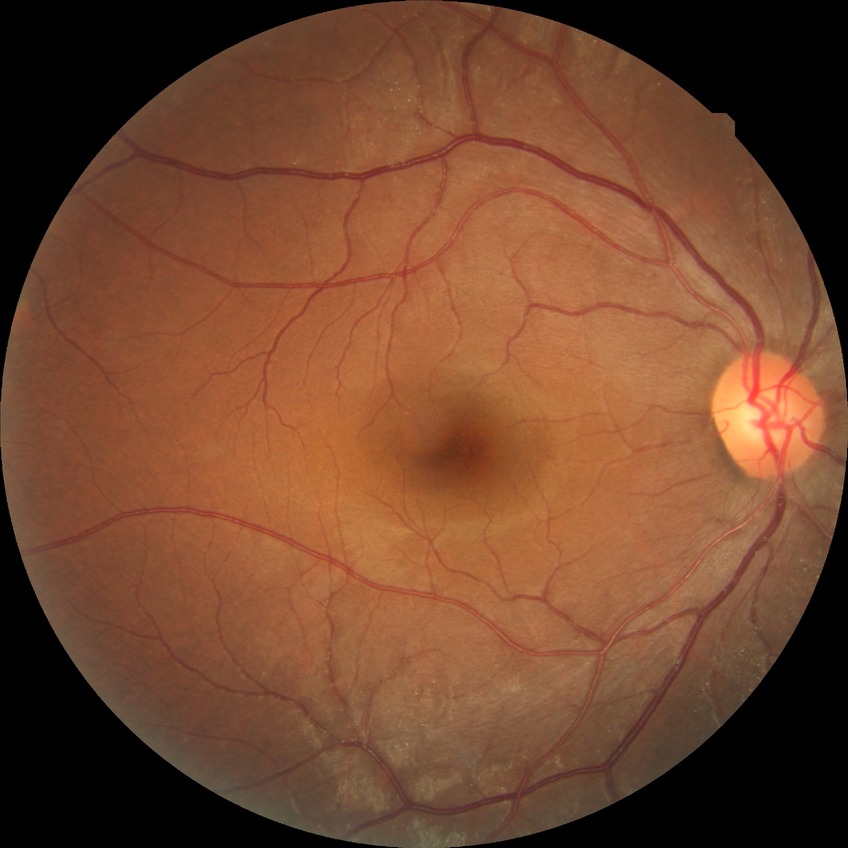

modified Davis grading: no diabetic retinopathy.